No pharmacologic dilation · NIDEK AFC-230 · retinal fundus photograph — 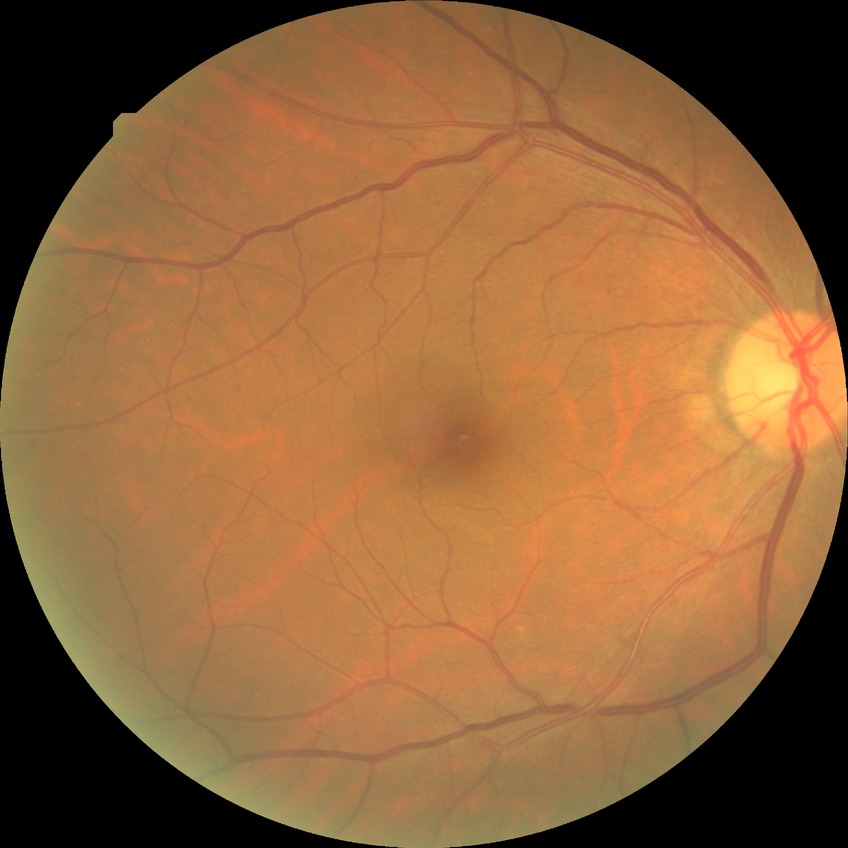
{
  "davis_grade": "NDR (no diabetic retinopathy)"
}